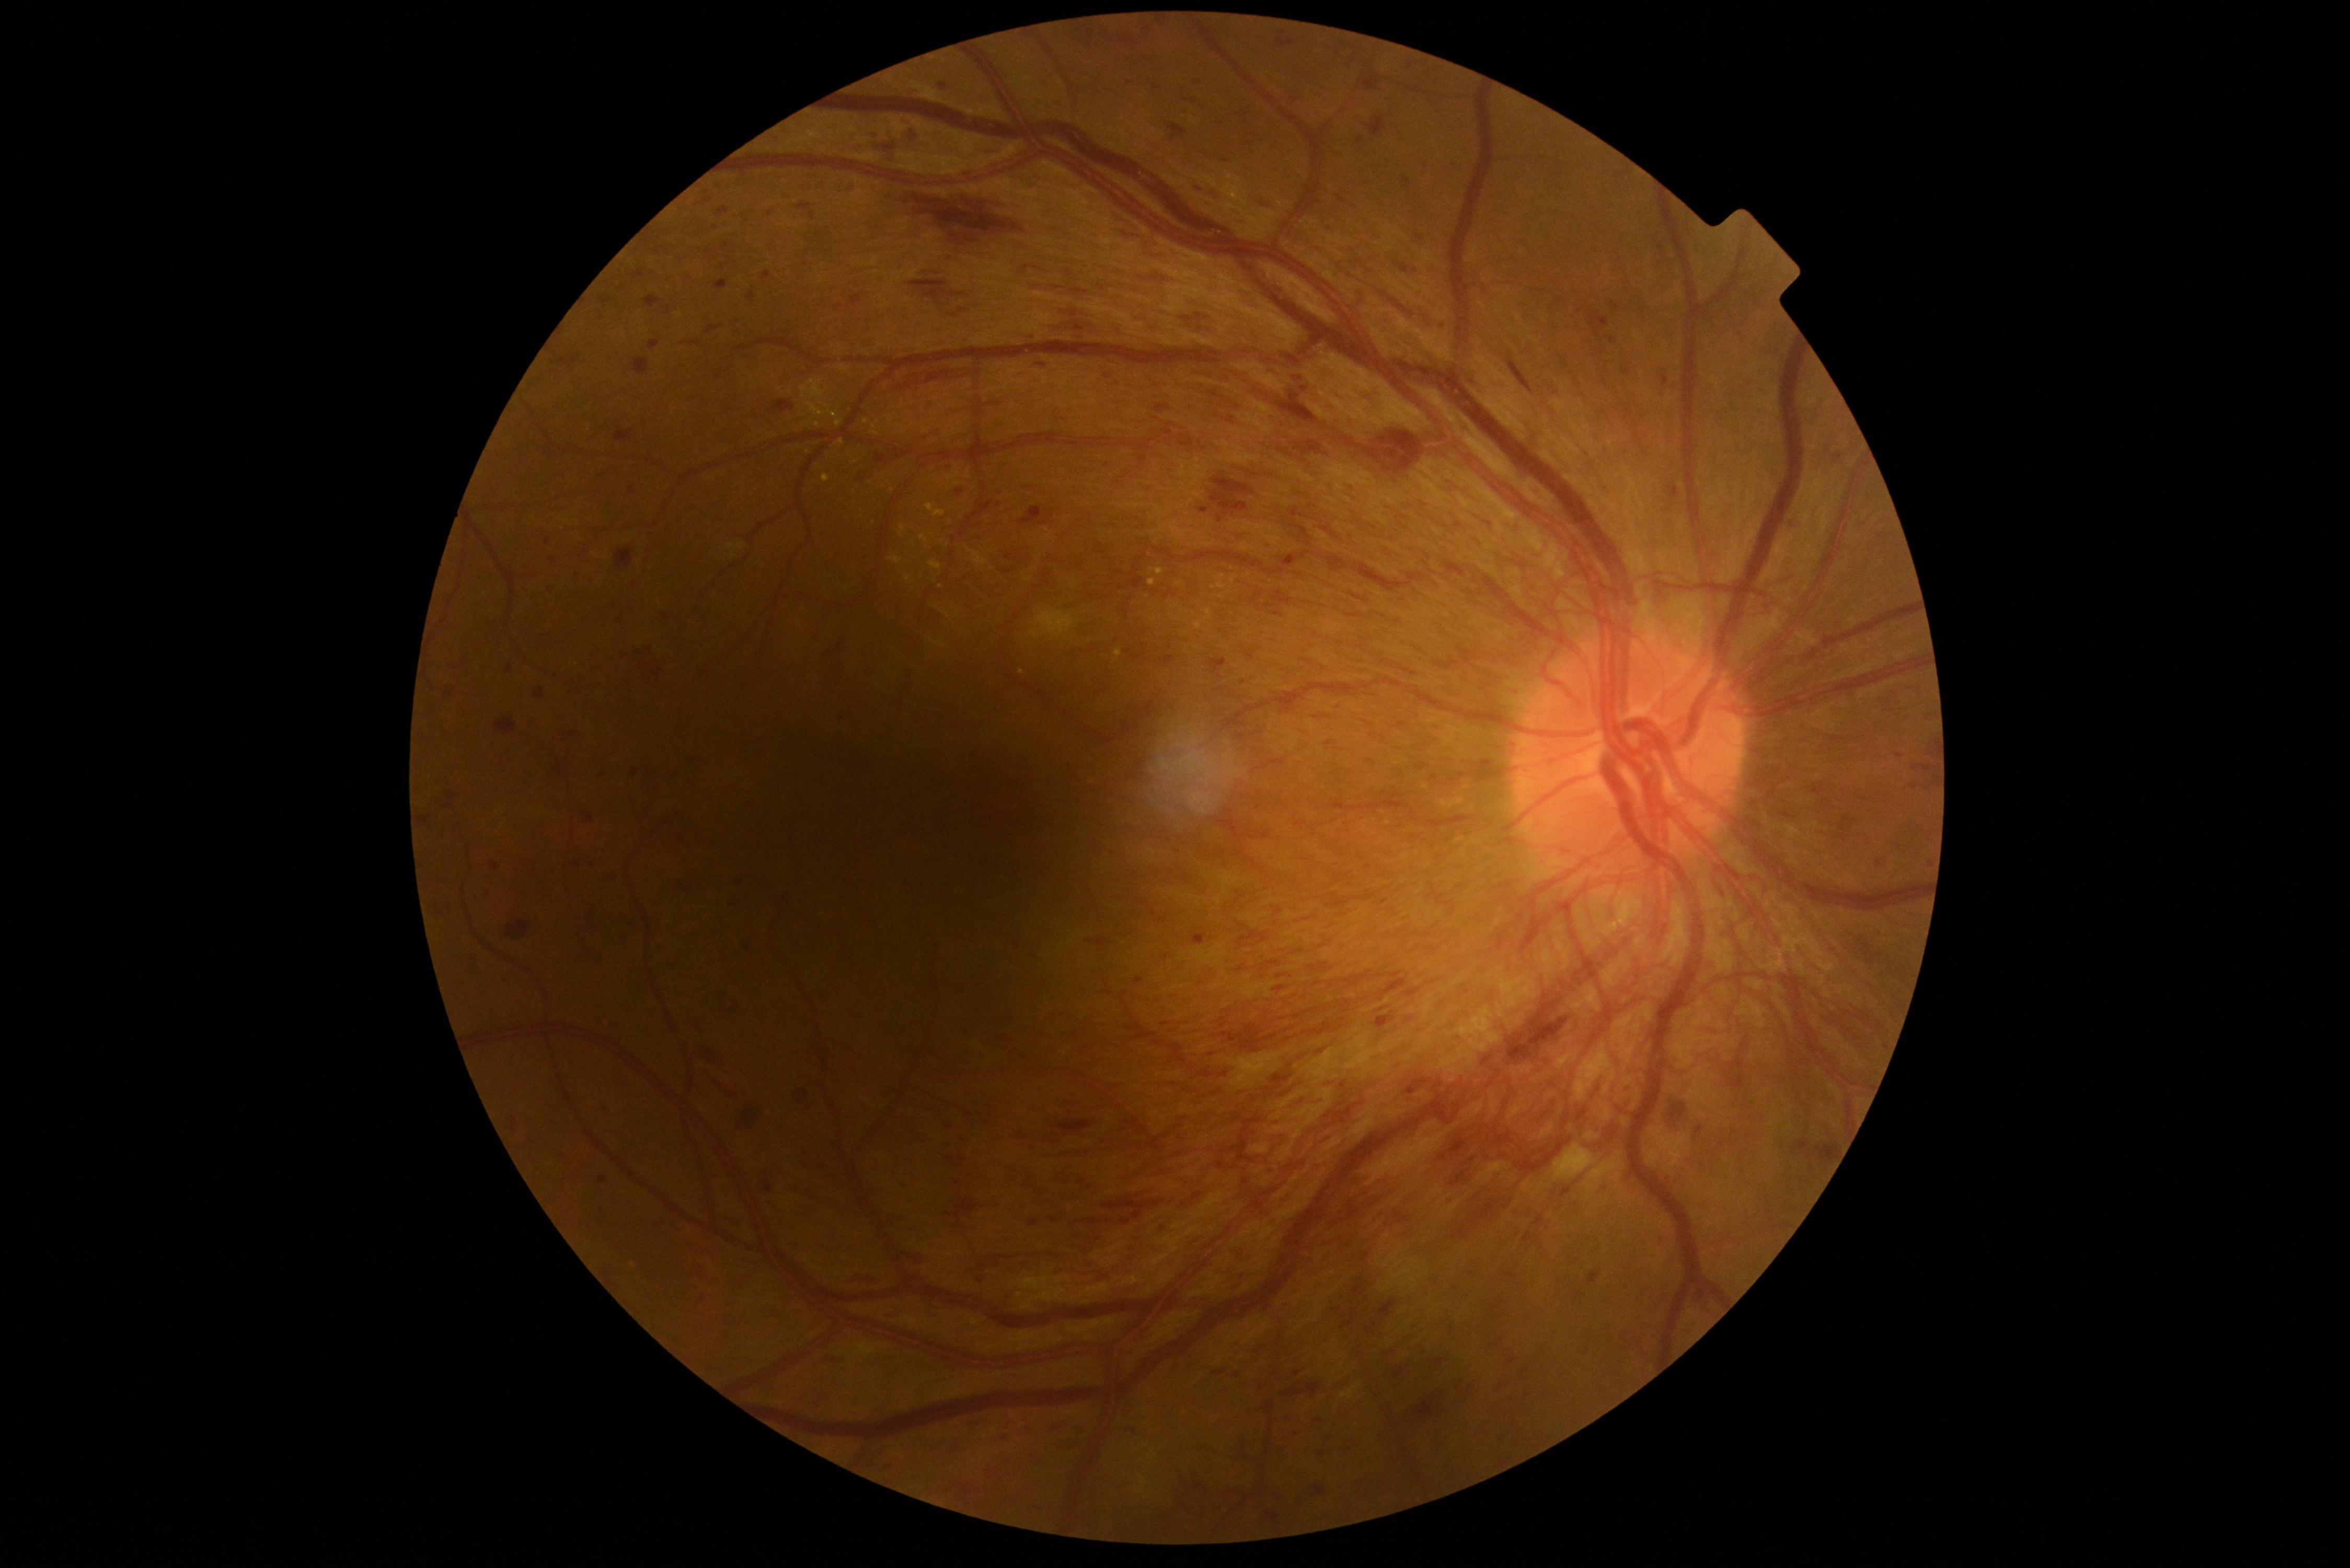
Annotations:
– DR stage: proliferative diabetic retinopathy (grade 4)
– DR class: proliferative diabetic retinopathy